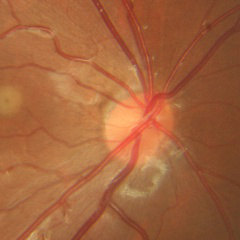 Q: What stage of glaucoma is present?
A: No glaucomatous changes.